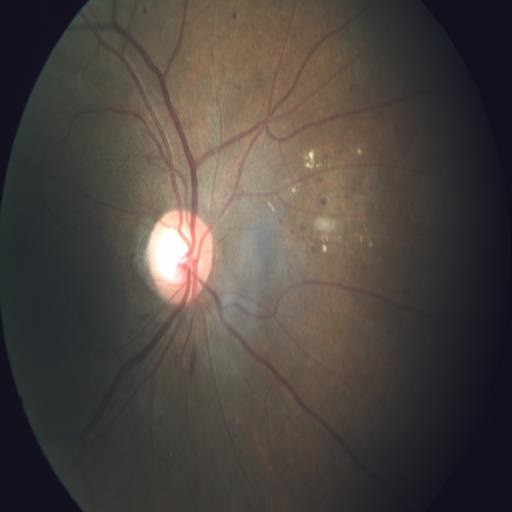 Diagnosis: cotton wool spots; exudation.